Acquired with a Kowa VX-10α; fundus photo.
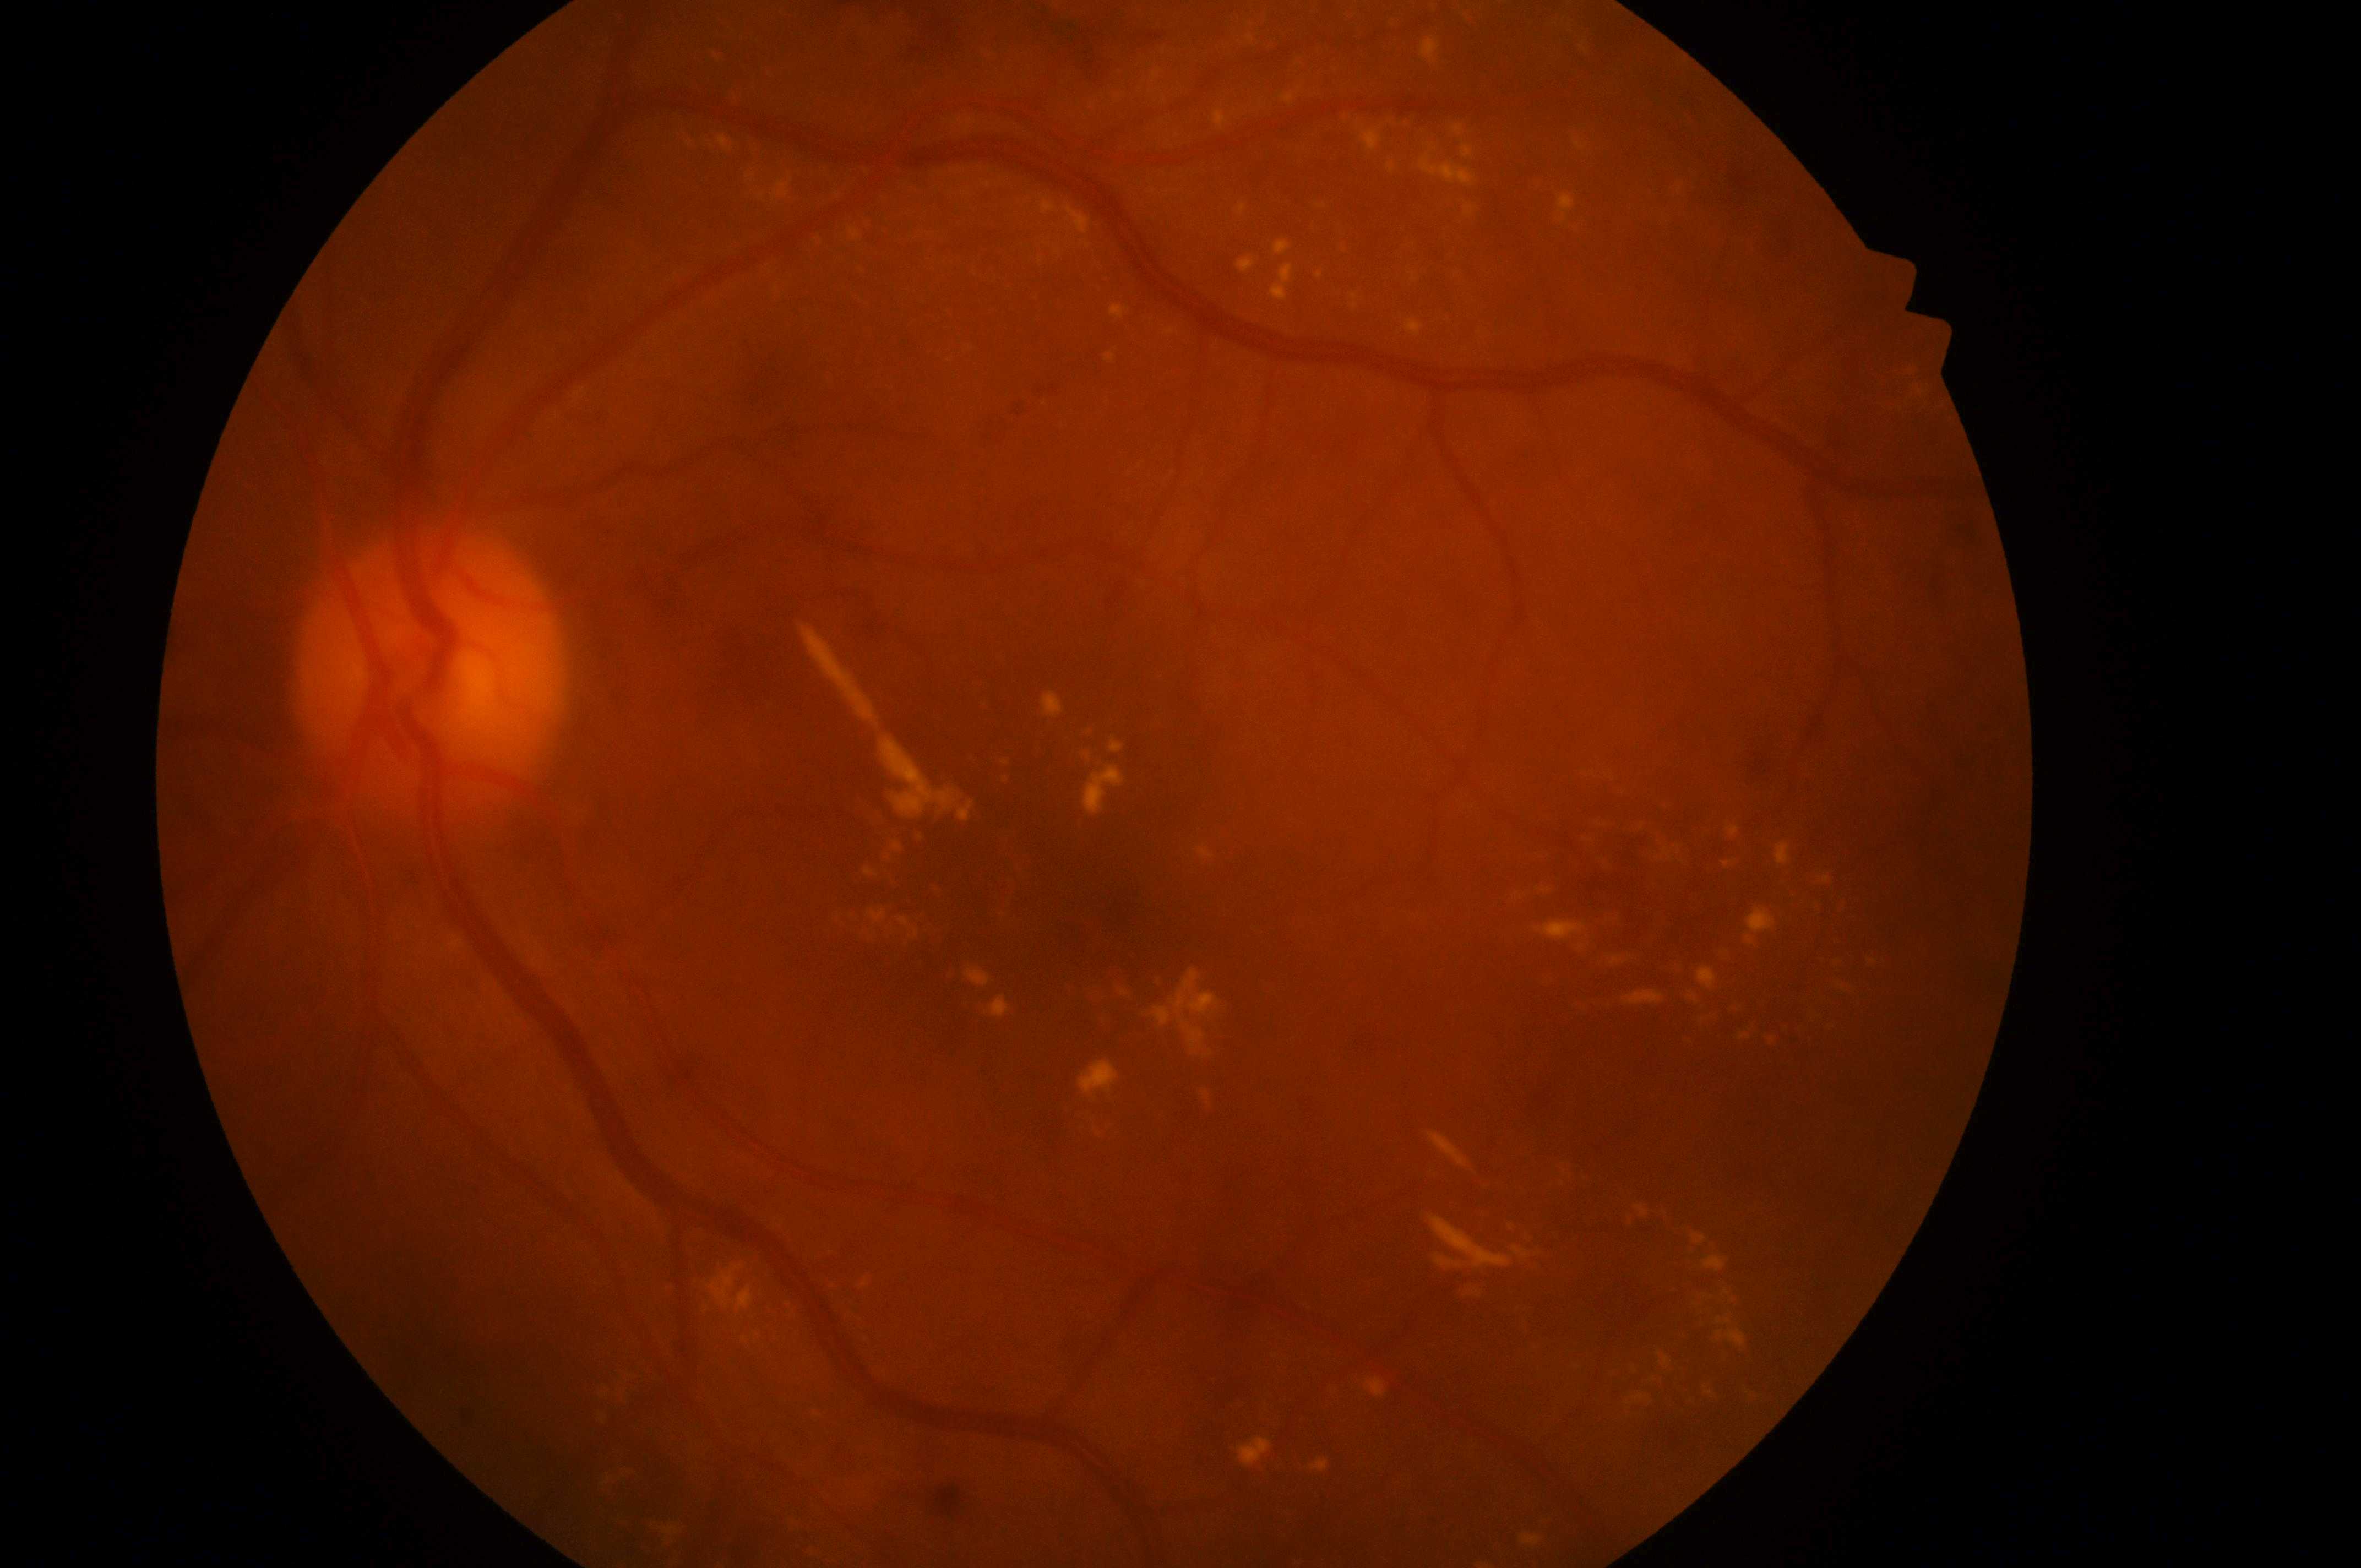

Macular edema: 2 — hard exudates within one disc diameter of the macula center. Imaged eye: the left eye. The fovea centralis is at x=1042, y=895. Diabetic retinopathy: 2/4 — more than just microaneurysms but less than severe NPDR. Optic disc: x=422, y=696.